Pediatric retinal photograph (wide-field) — 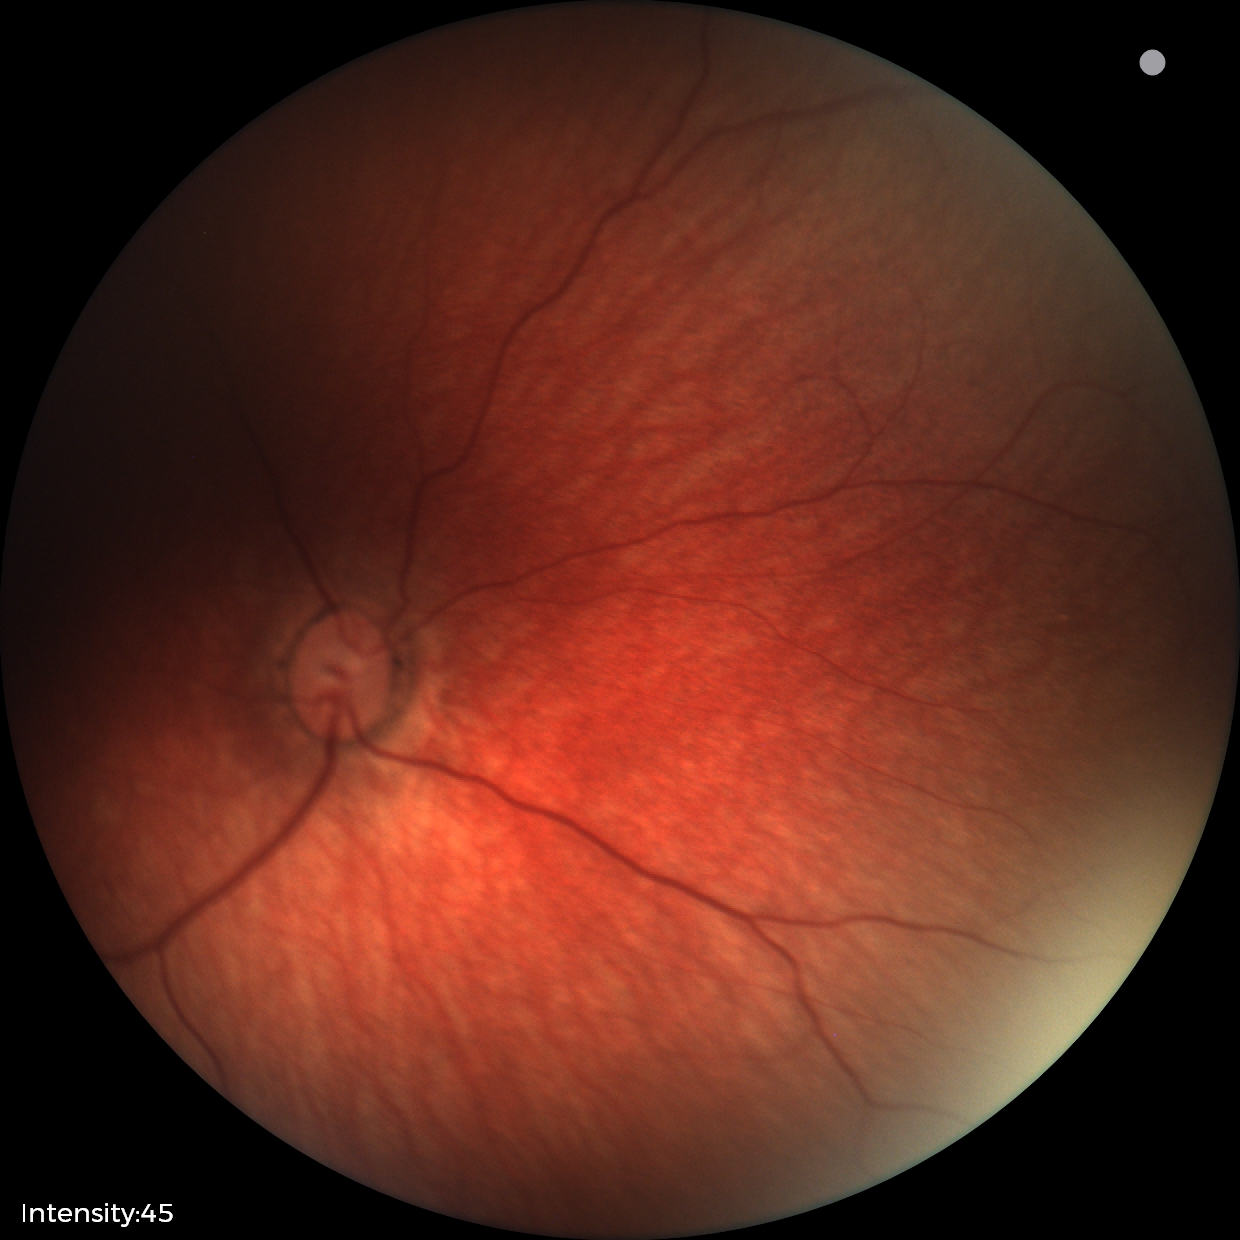 Physiological retinal appearance for postconceptual age.